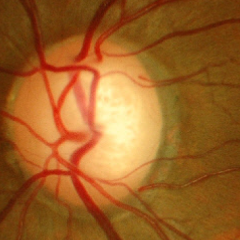

Q: What is the glaucoma diagnosis?
A: No glaucomatous changes.